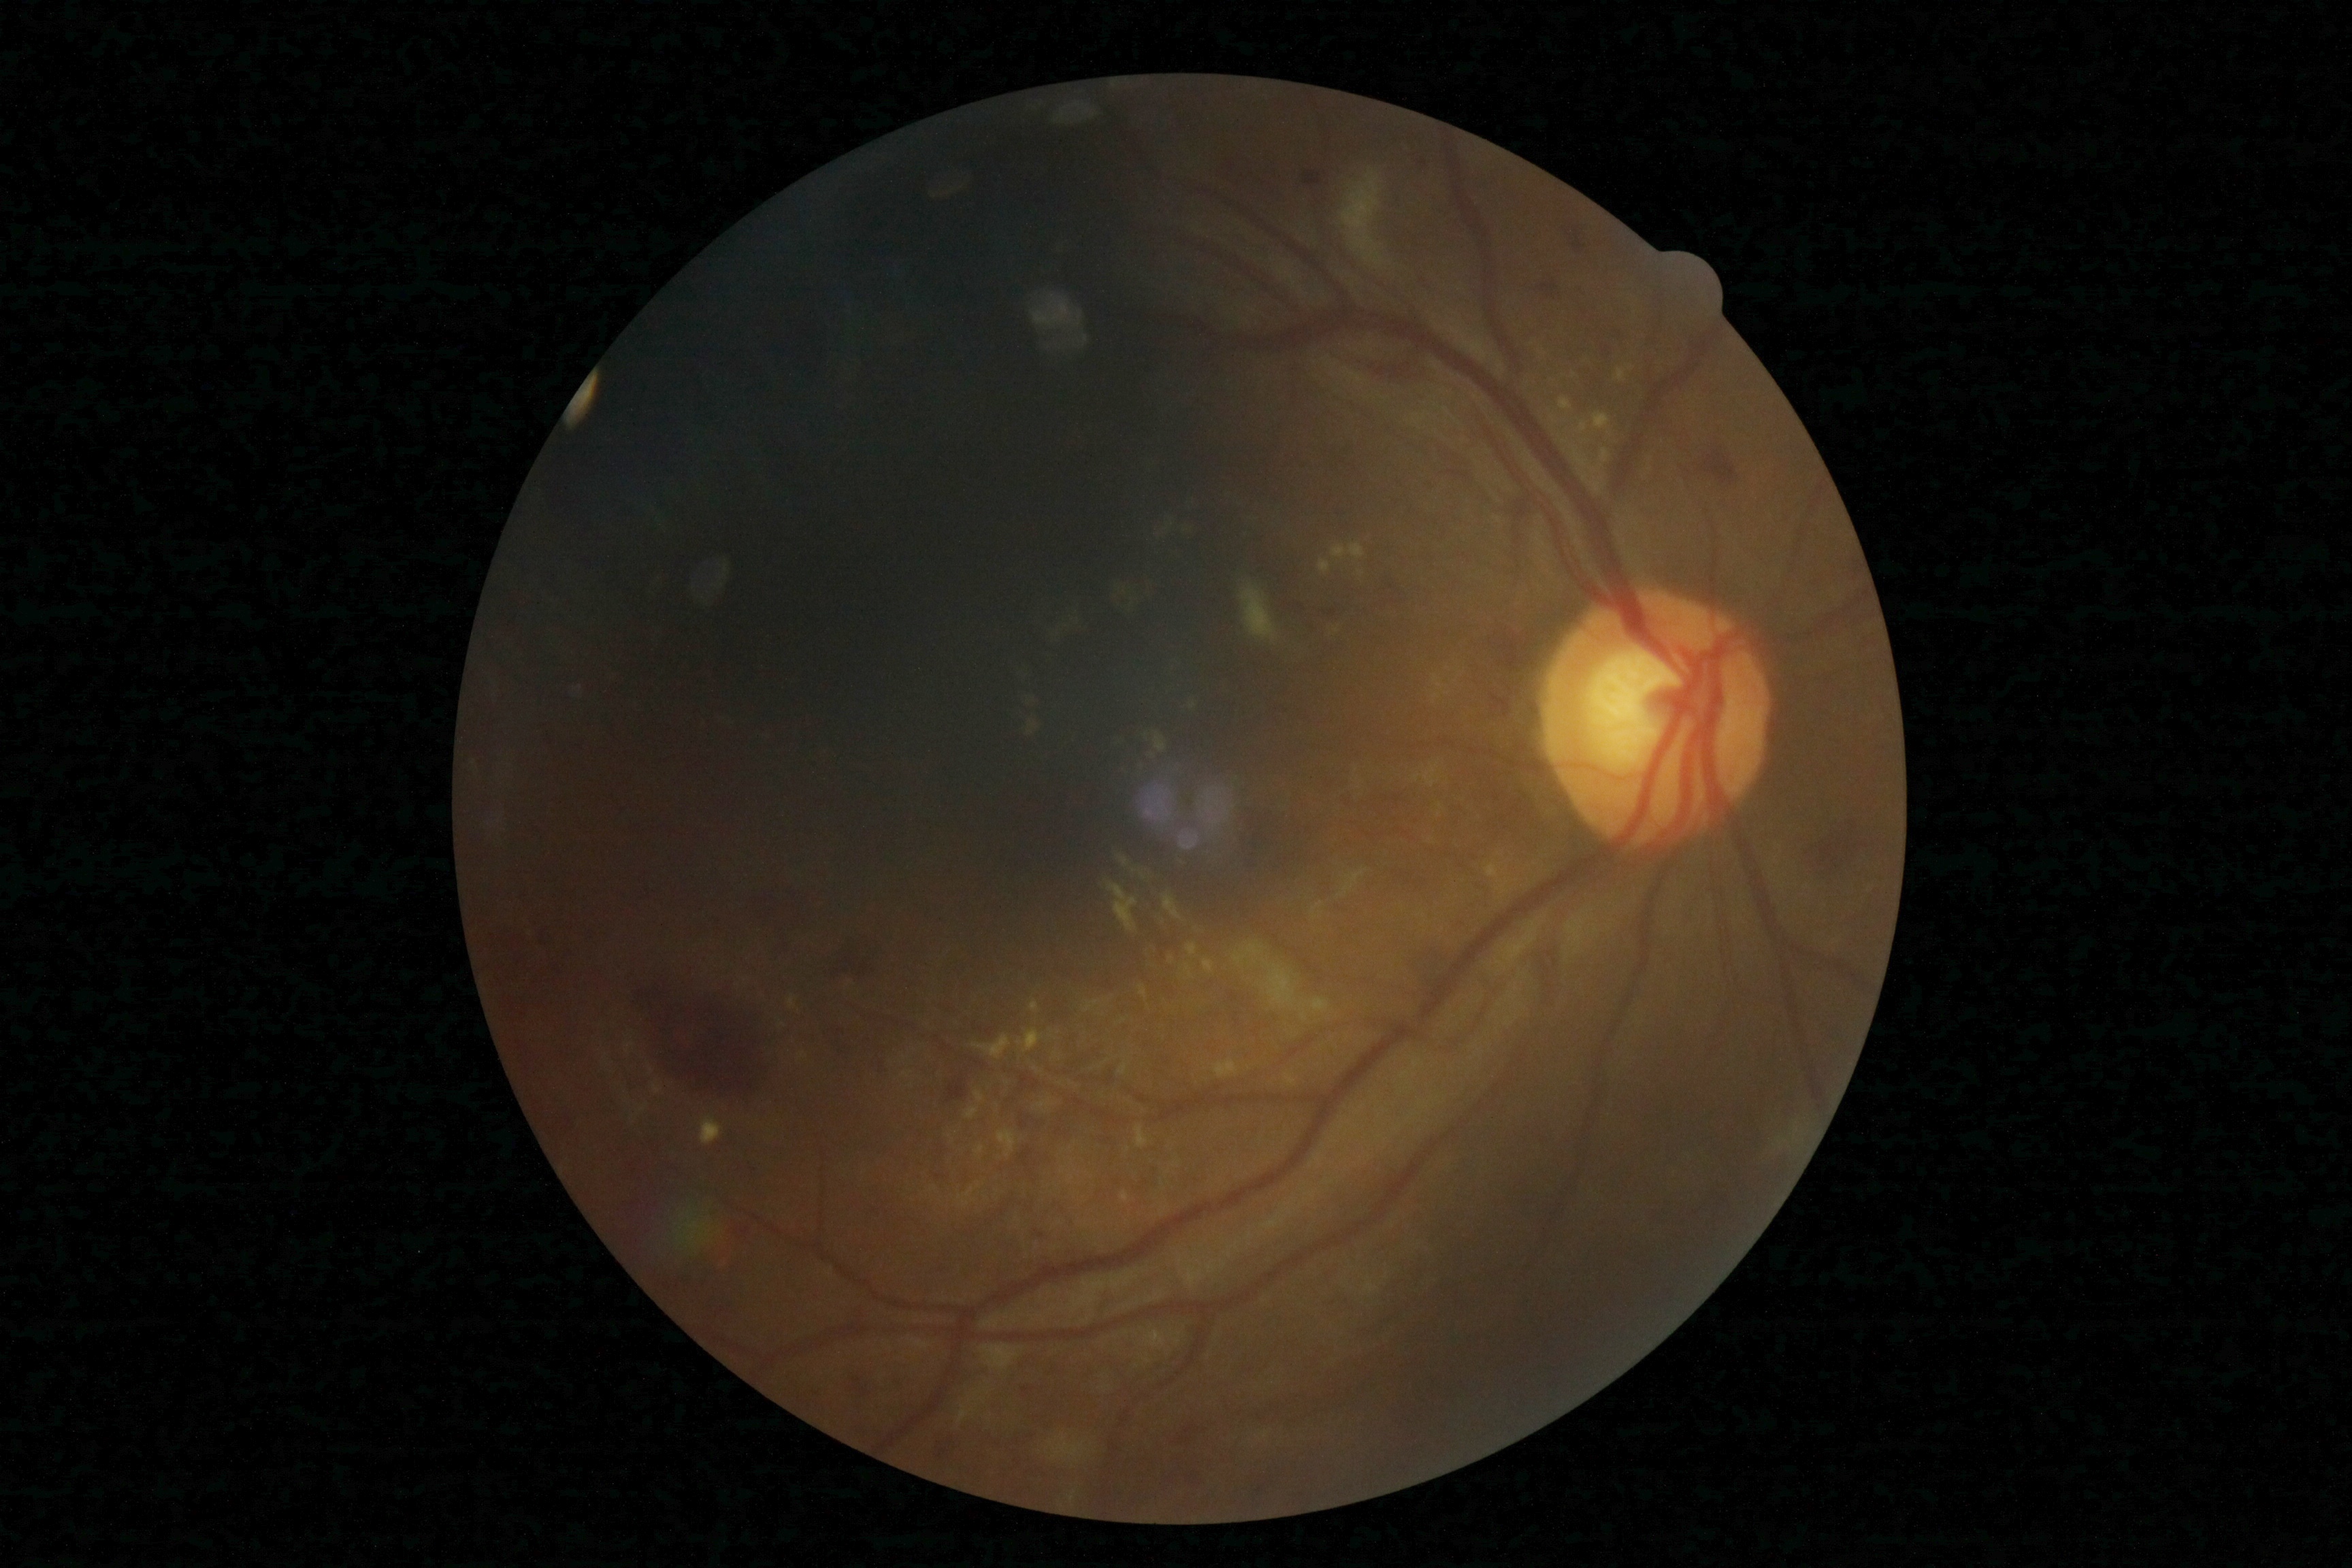

Diabetic retinopathy severity is moderate NPDR (grade 2).